Nidek AFC-330.
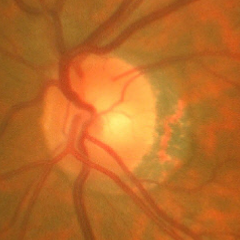 Glaucoma assessment: early-stage glaucoma.